Tabletop color fundus camera image — 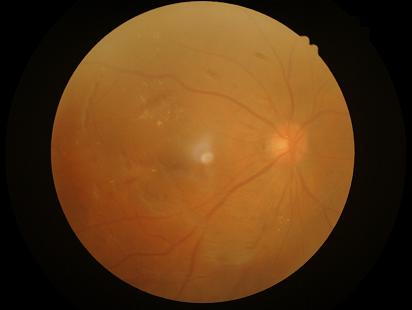

Illumination is uneven.
Image quality is inadequate for diagnostic use.
Good dynamic range.
Noticeable blur in the optic disc, vessels, or background.